Wide-field retinal mosaic image
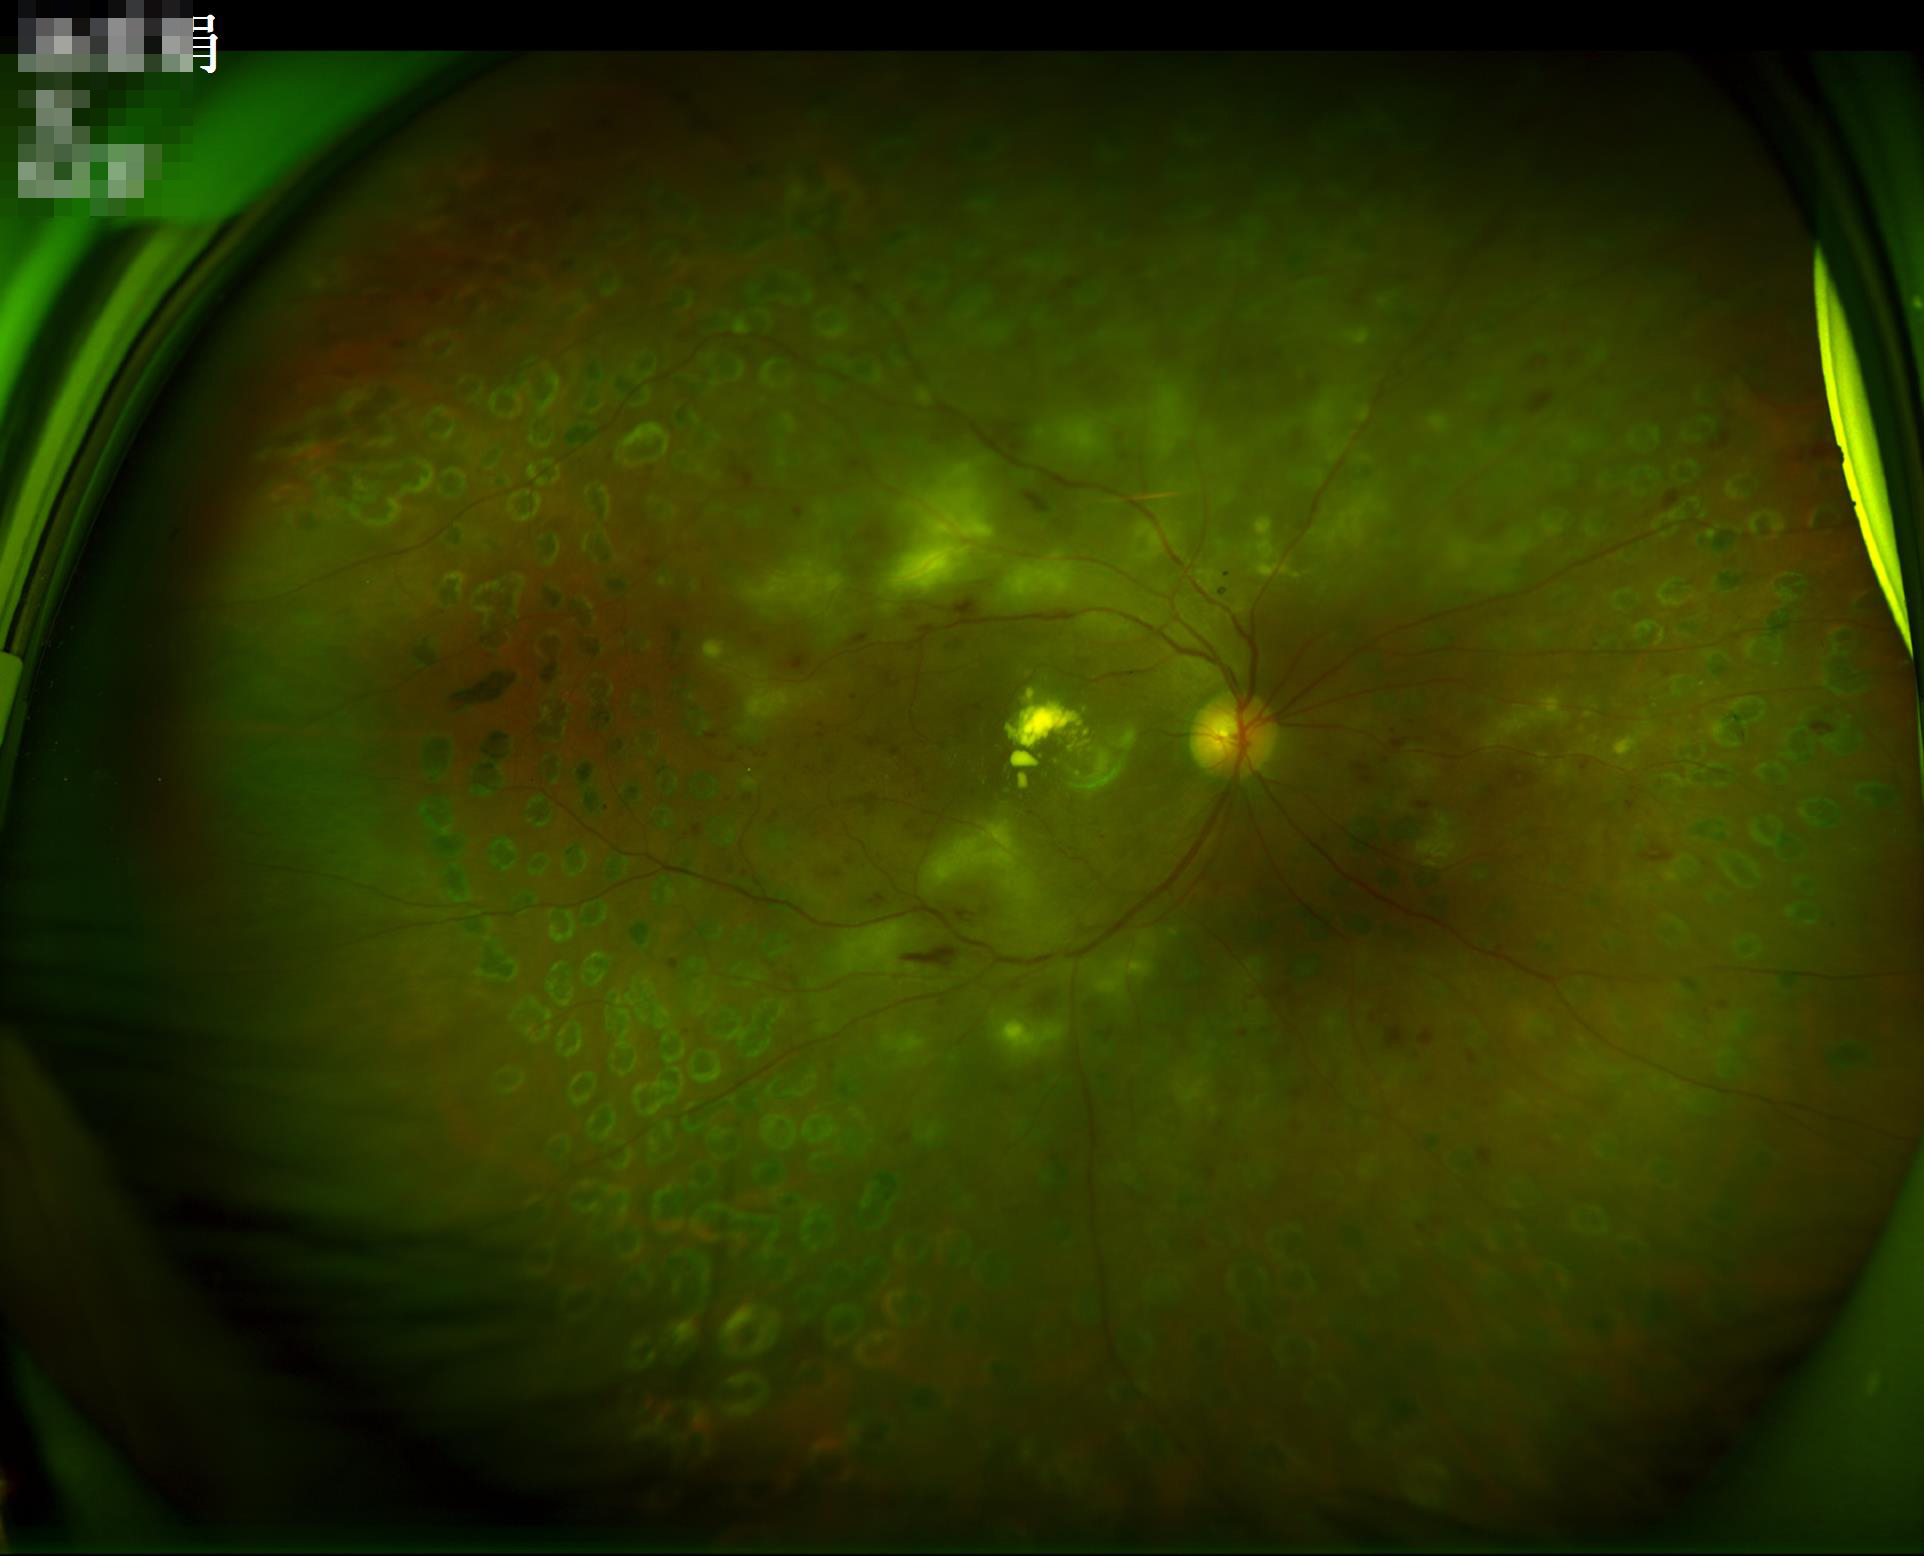 Vessels and details are readily distinguishable. Illumination and color balance are good. Overall image quality is good. The image is clear.